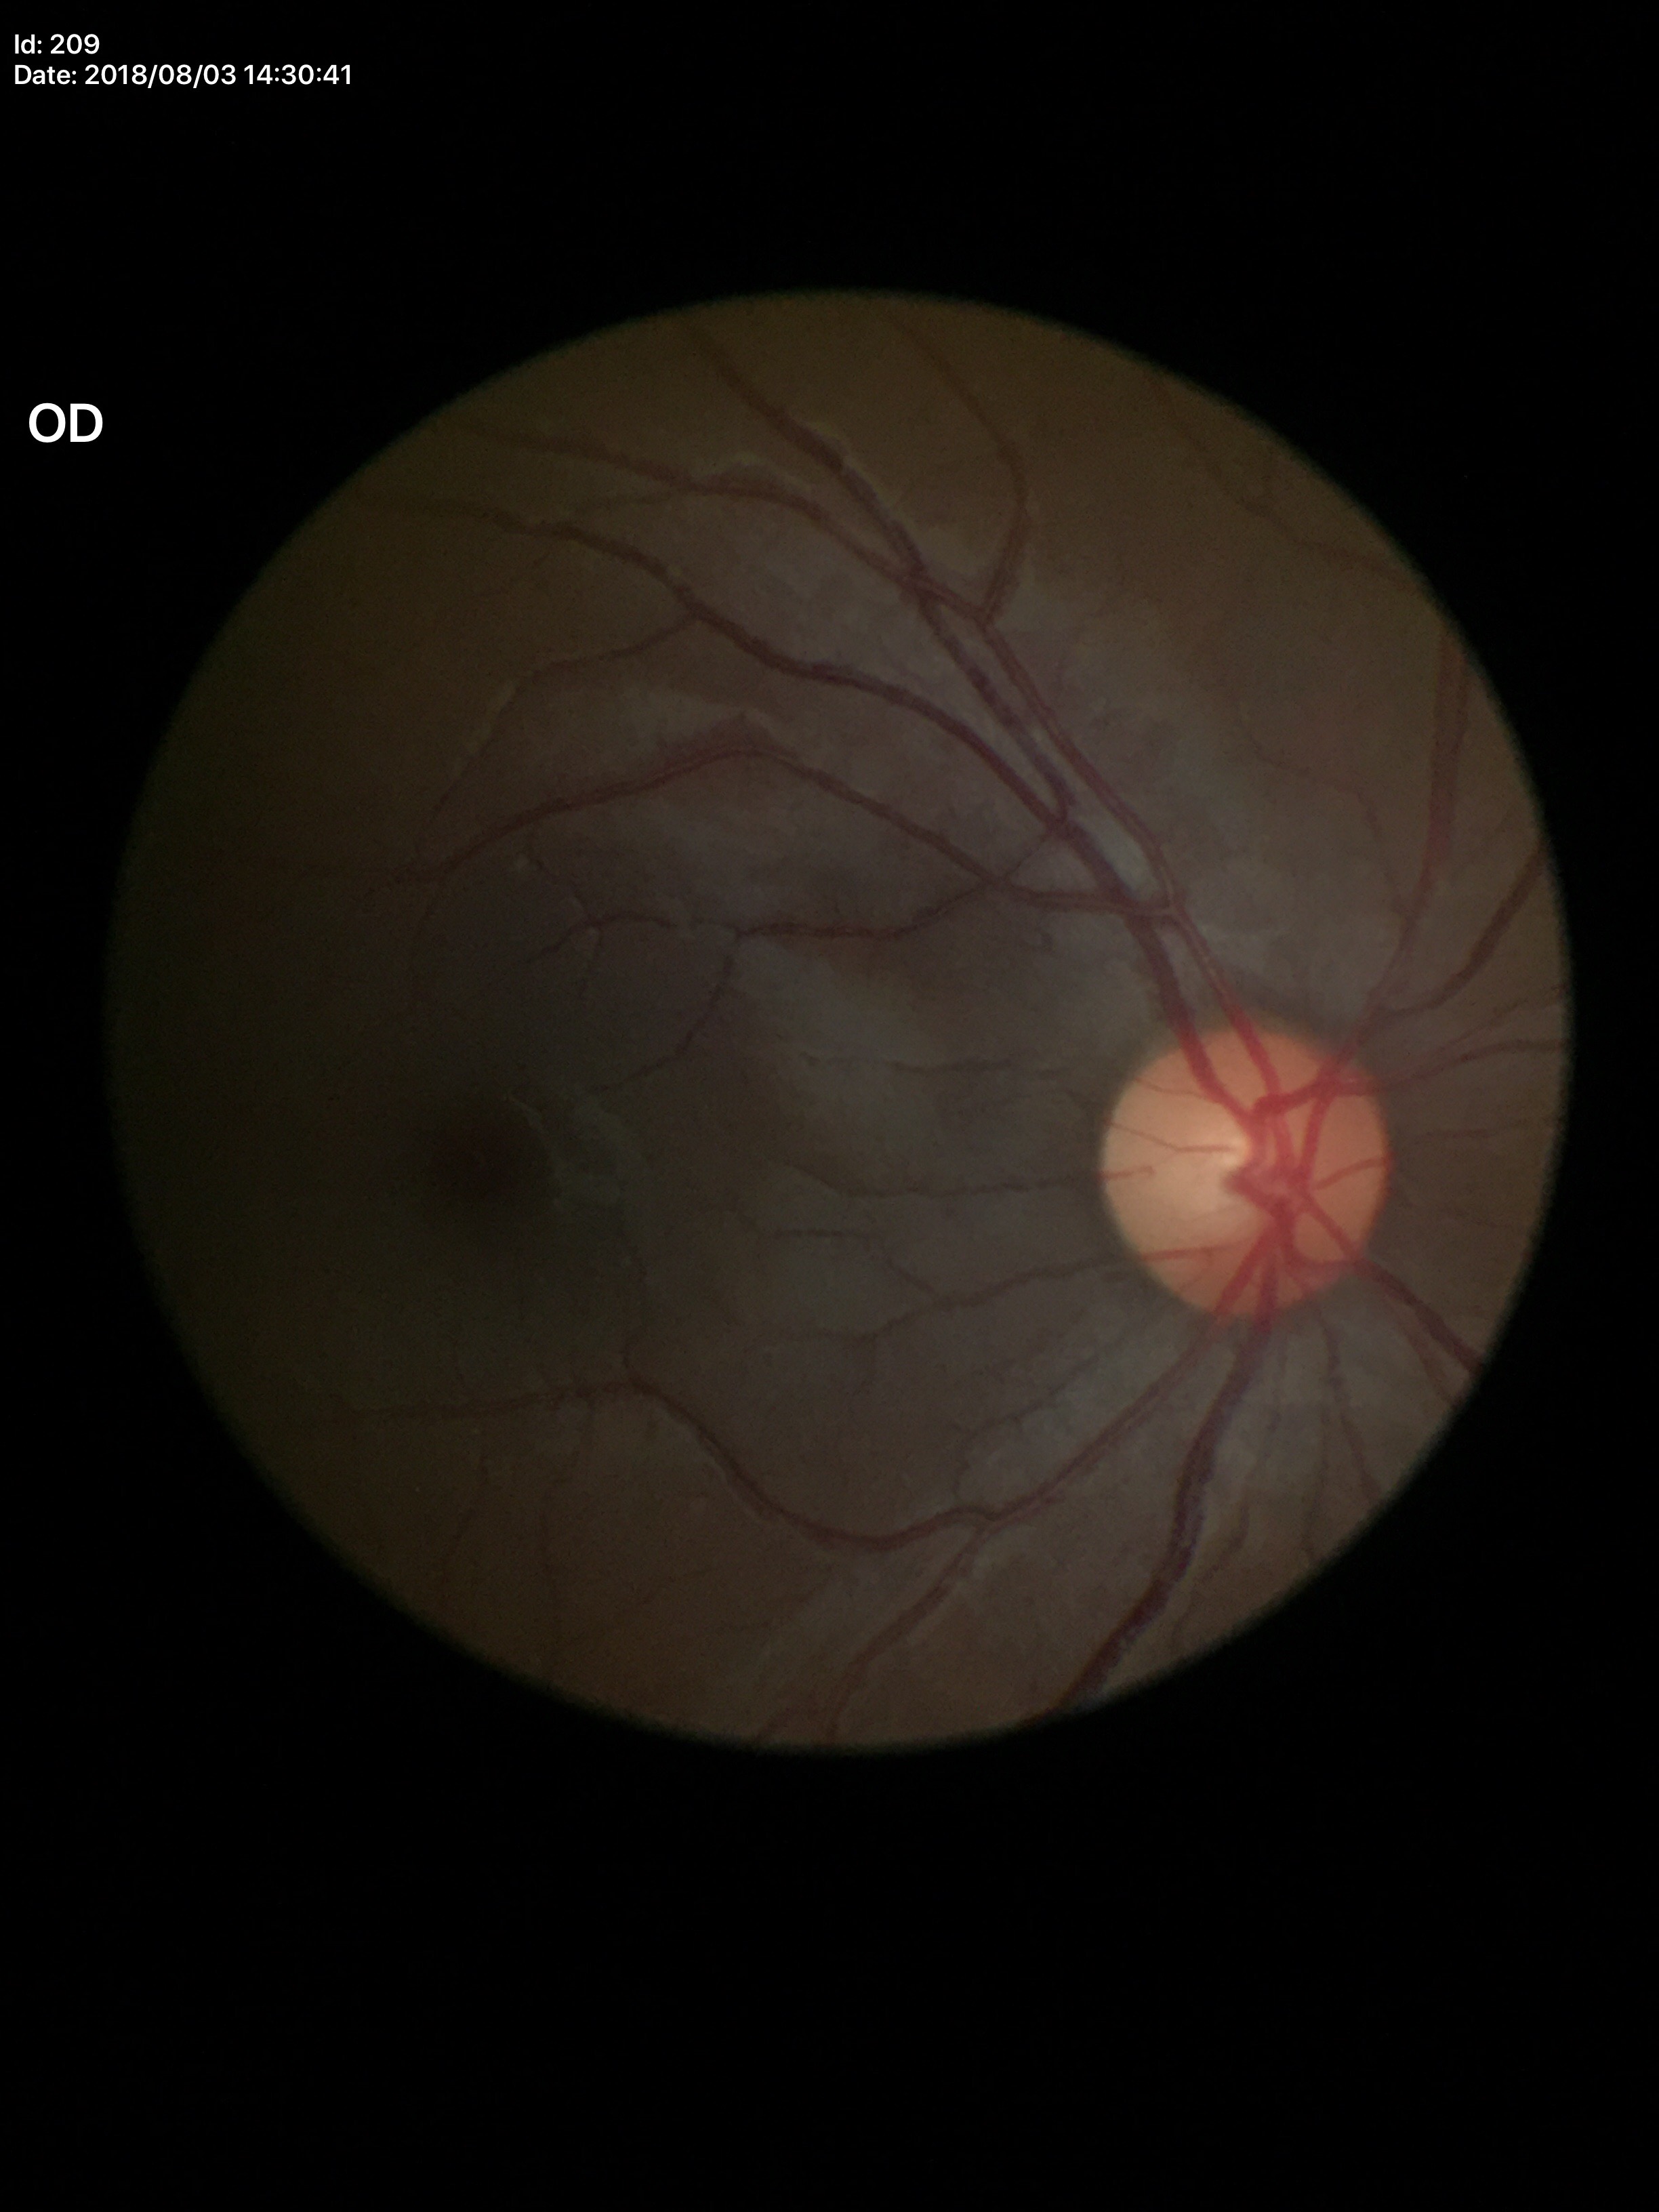

vertical C/D ratio: 0.45 | horizontal C/D ratio: 0.41 | Glaucoma screening: negative (unanimous normal call) | area C/D ratio: 0.18.